Image size 848x848 · DR severity per modified Davis staging — 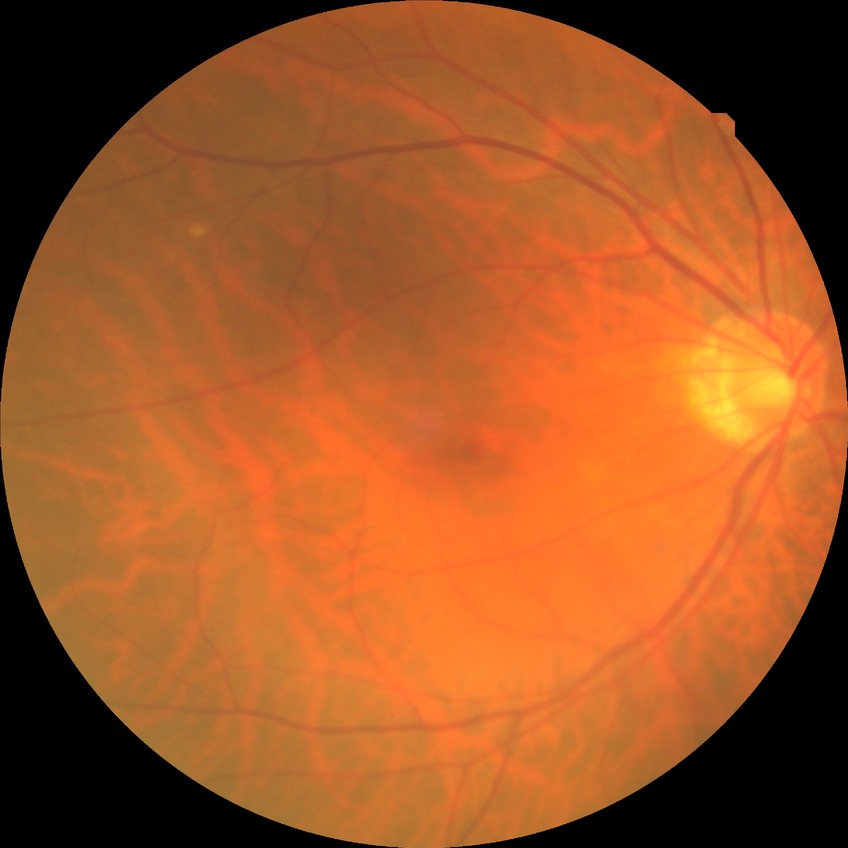
Diabetic retinopathy (DR): no diabetic retinopathy (NDR).